Fundus photo
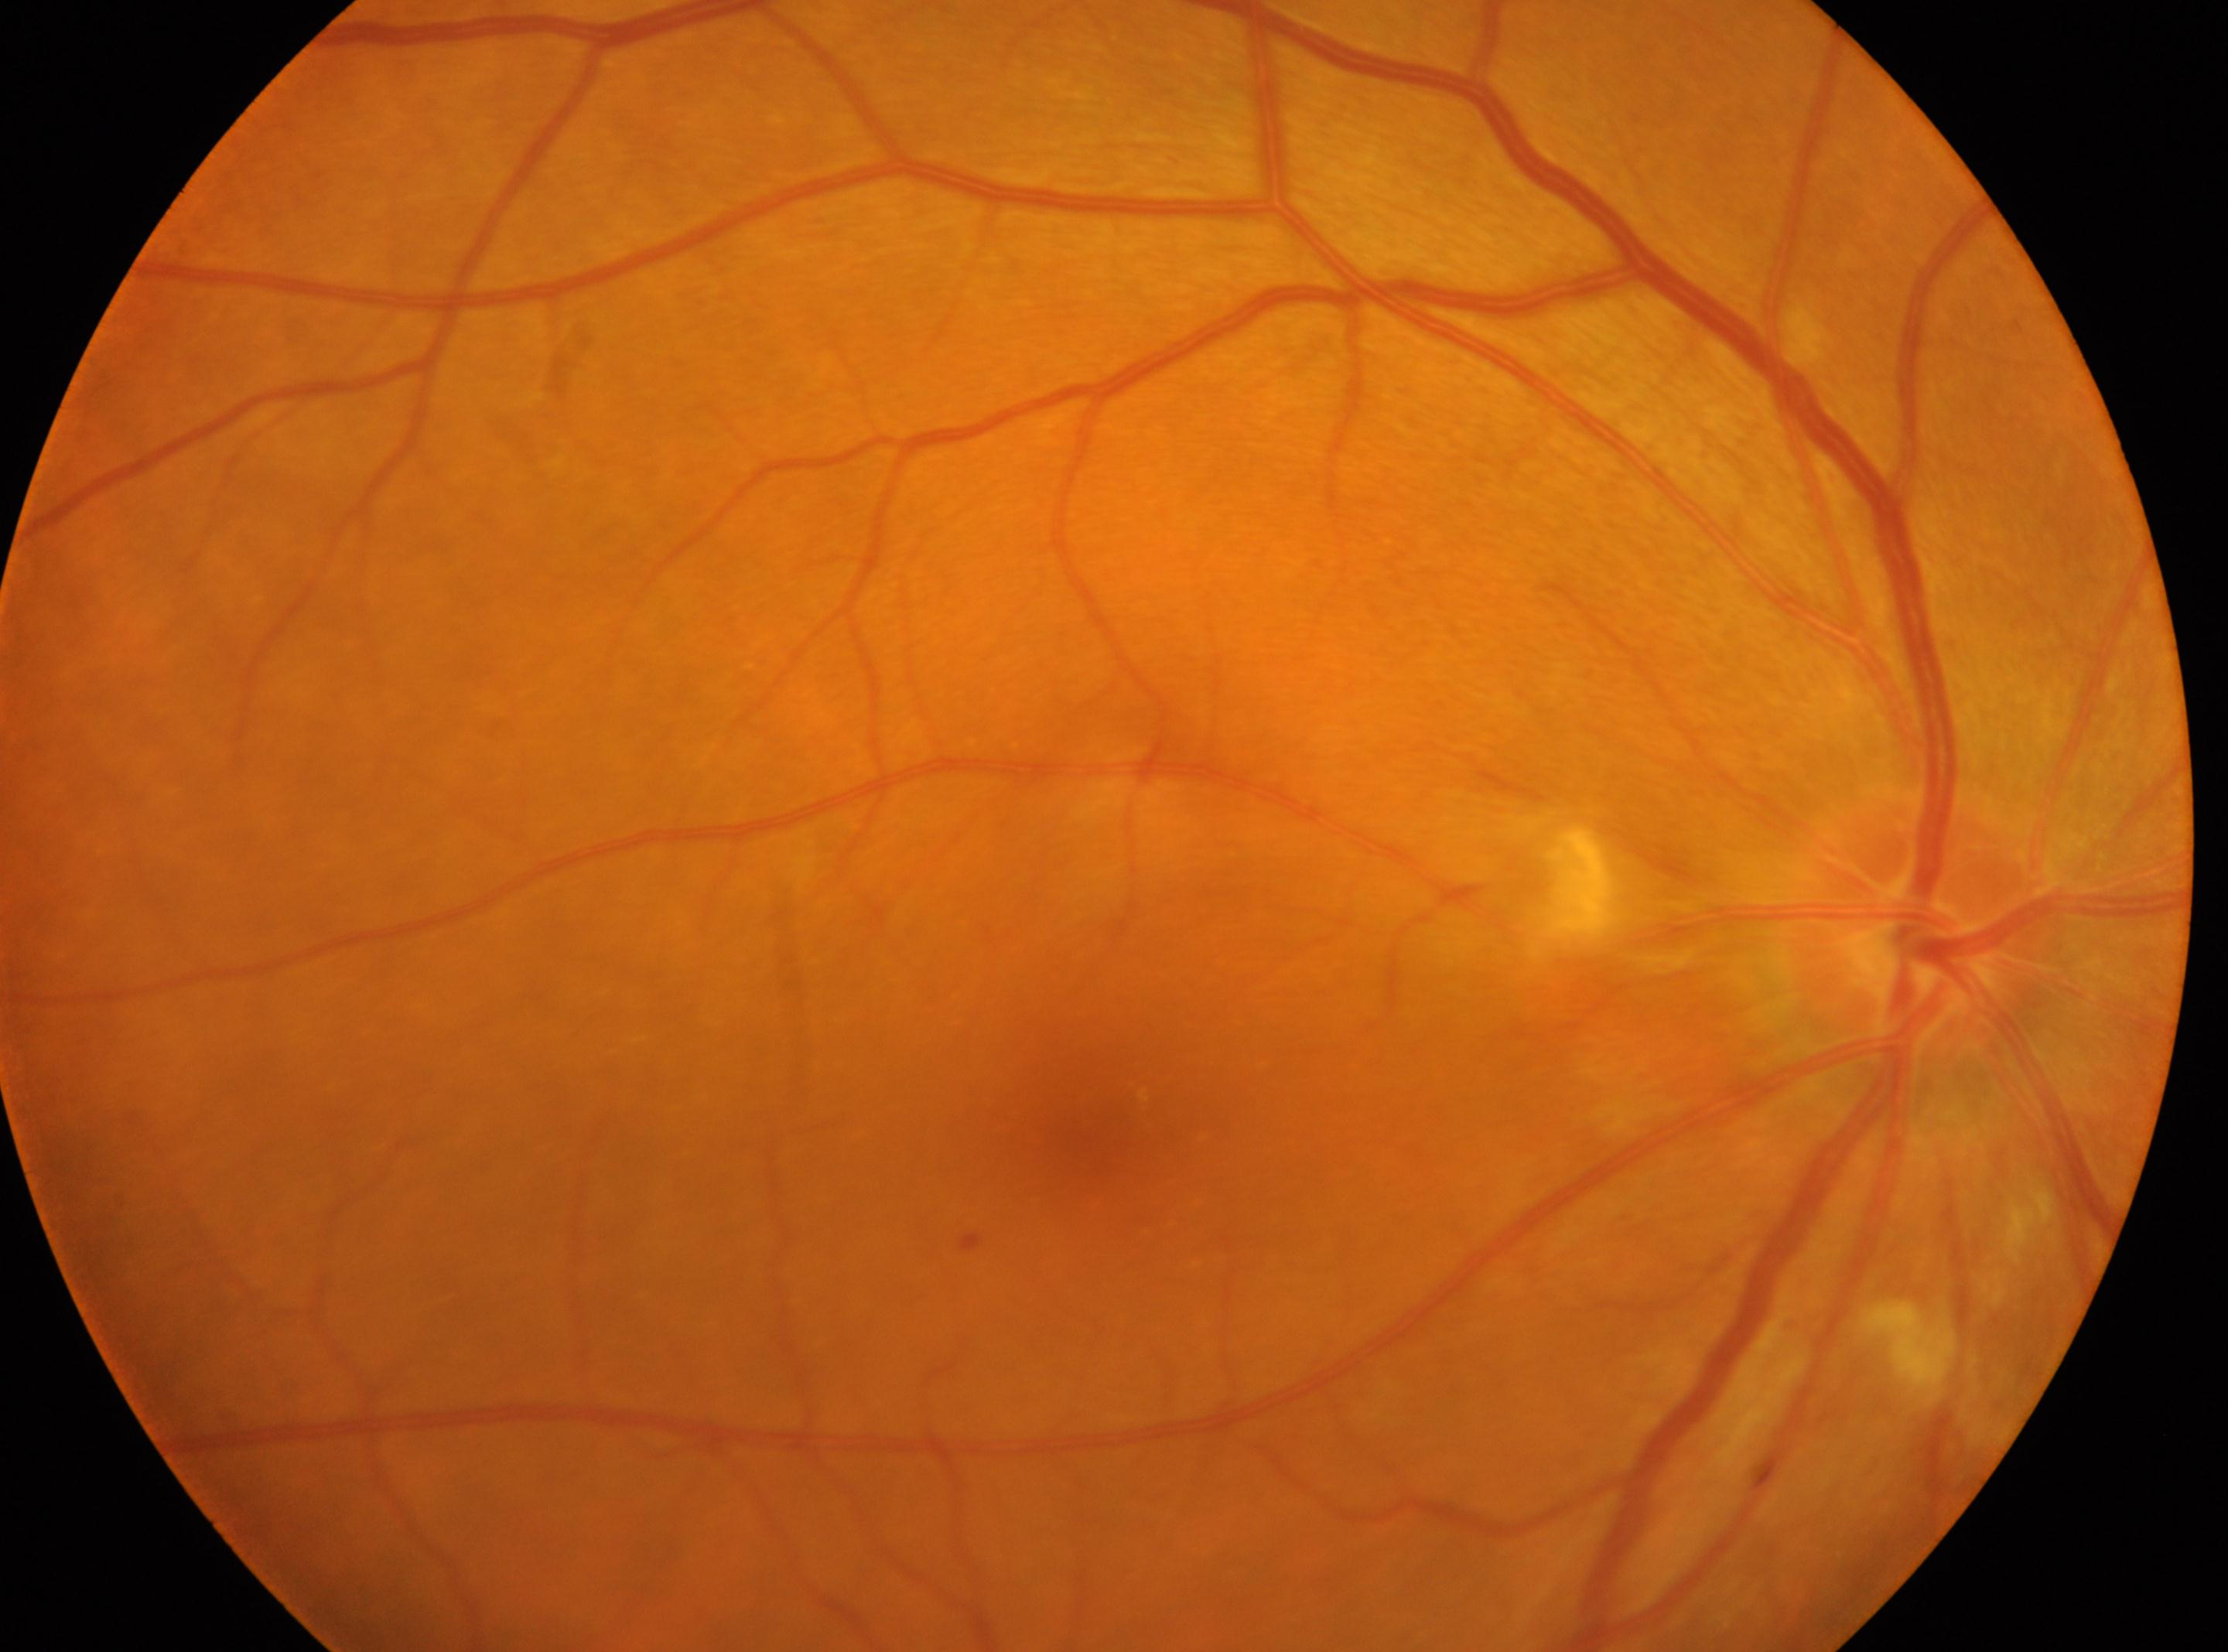
Q: Fovea center?
A: (1091,1129)
Q: Which eye is imaged?
A: right eye
Q: Where is the optic disc?
A: (1915,930)
Q: Diabetic retinopathy severity?
A: 2 (moderate NPDR)